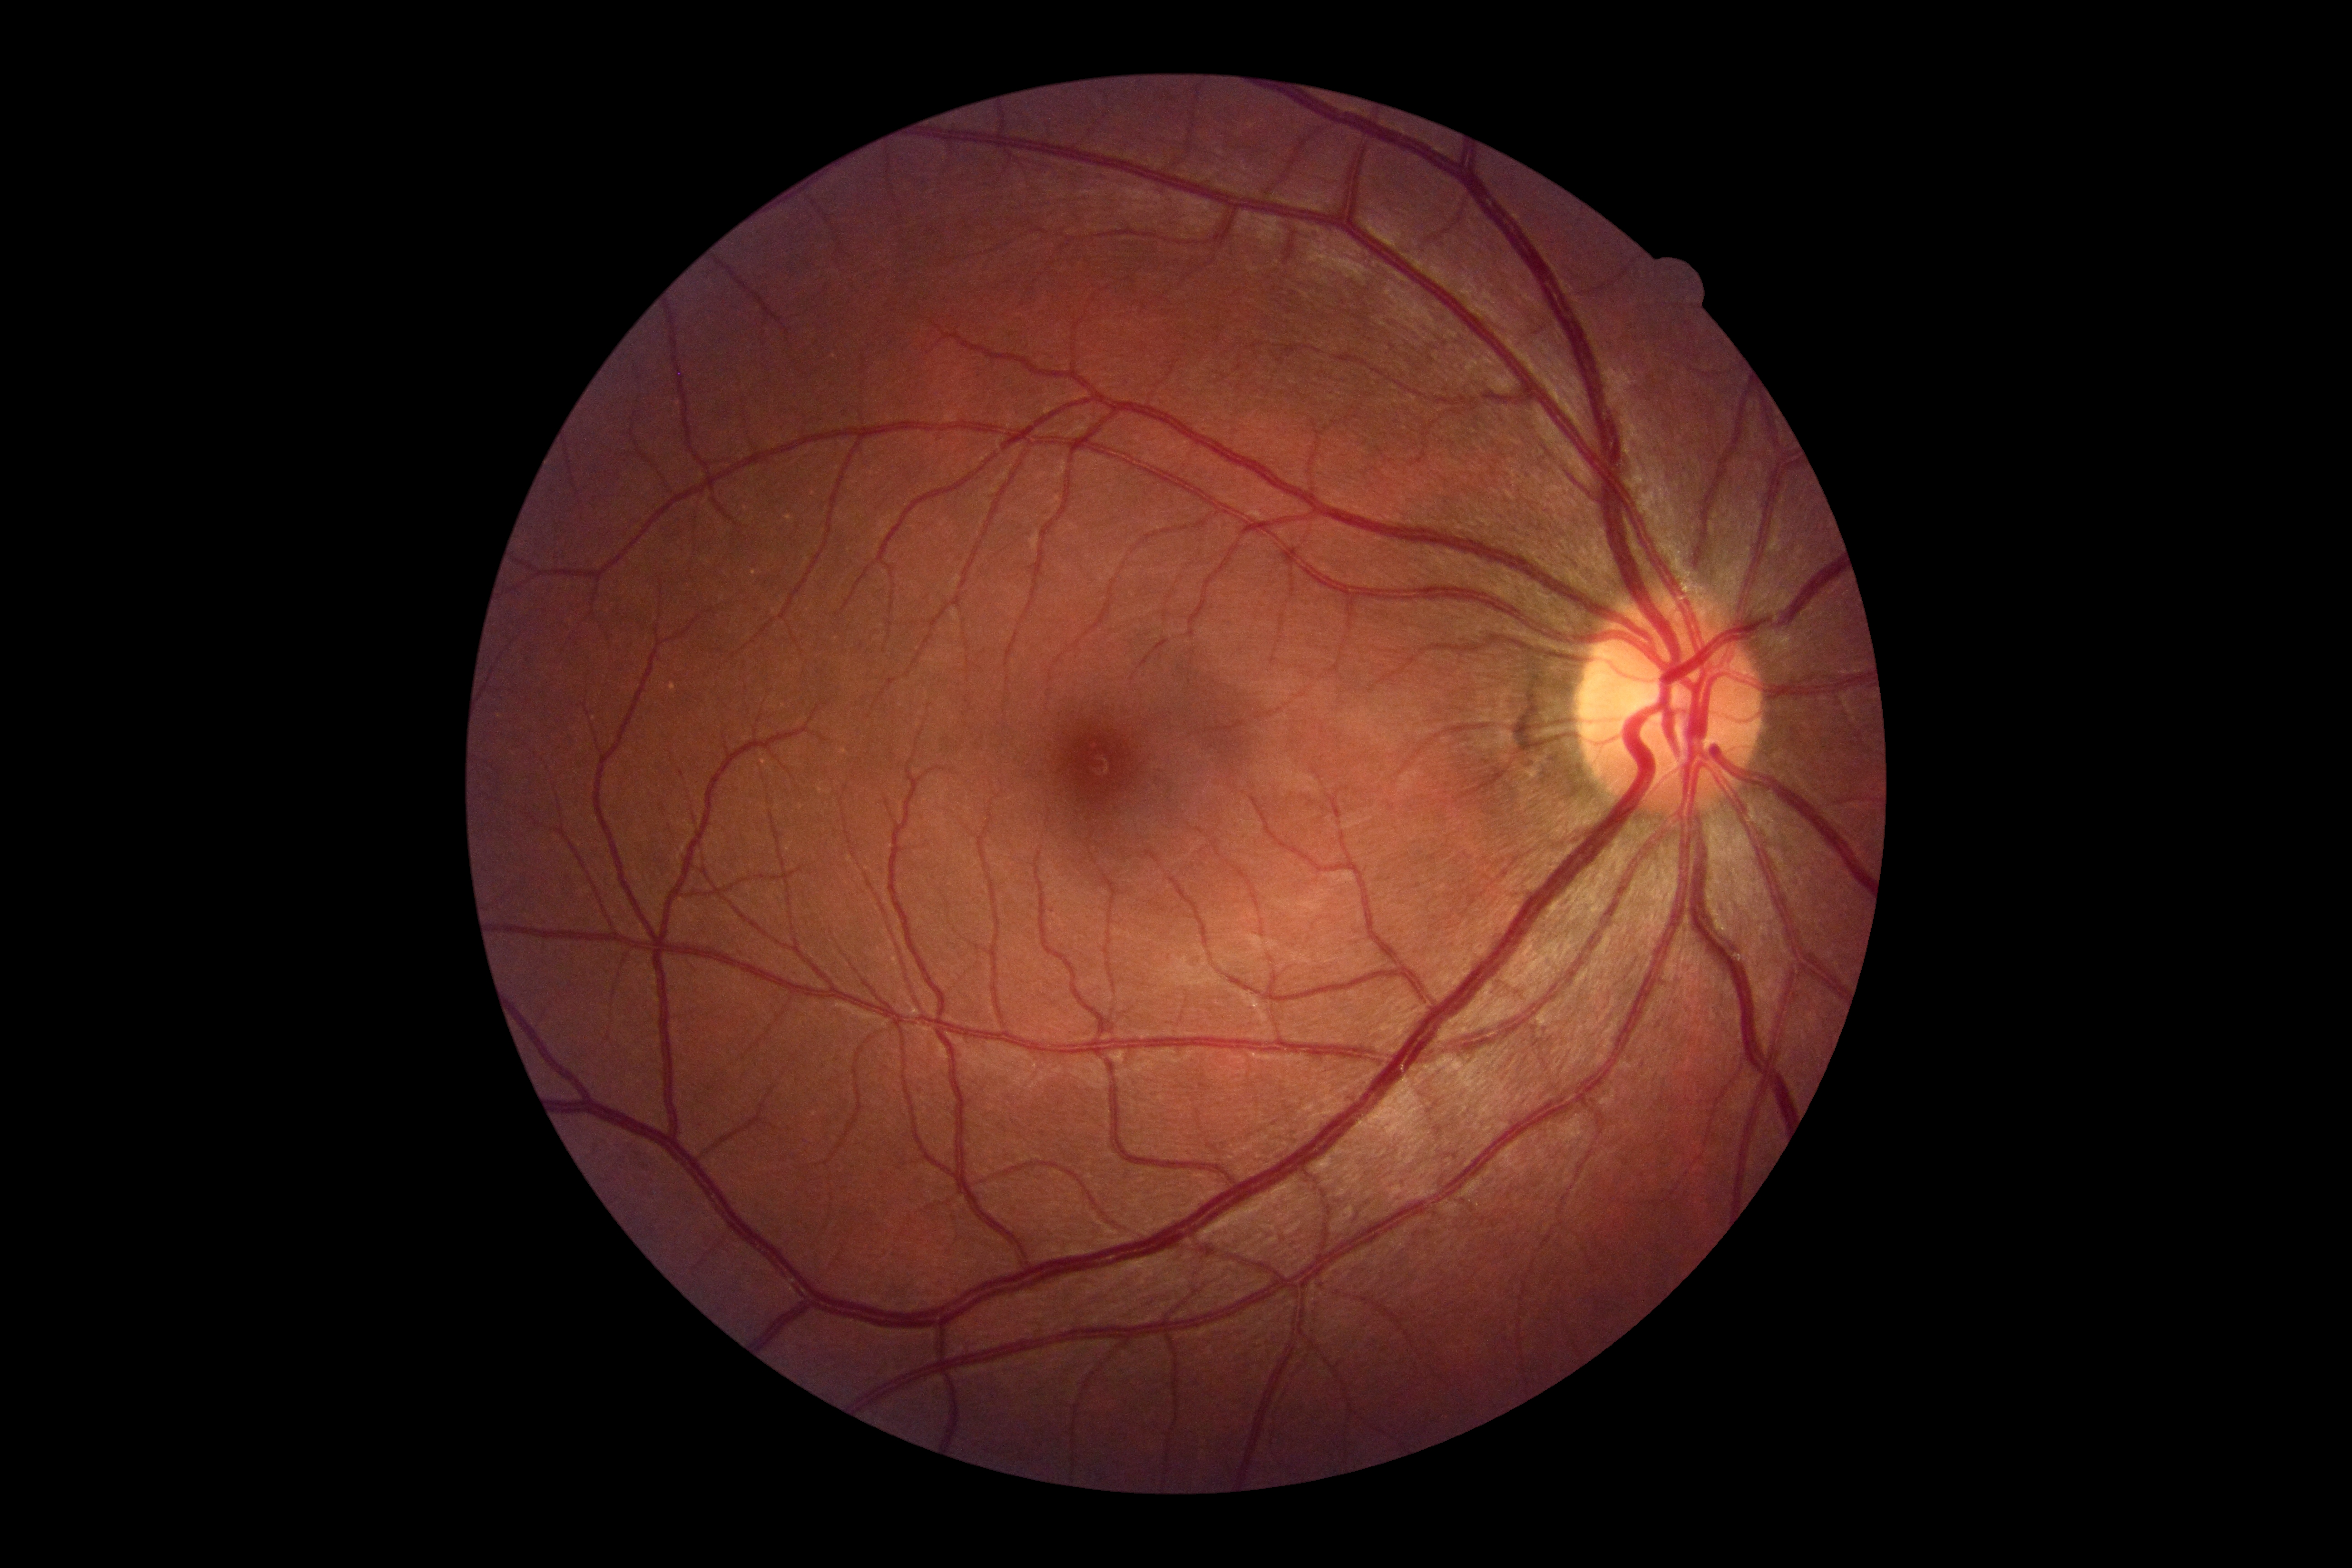 No signs of diabetic retinopathy.
Diabetic retinopathy (DR) is grade 0 (no apparent retinopathy).